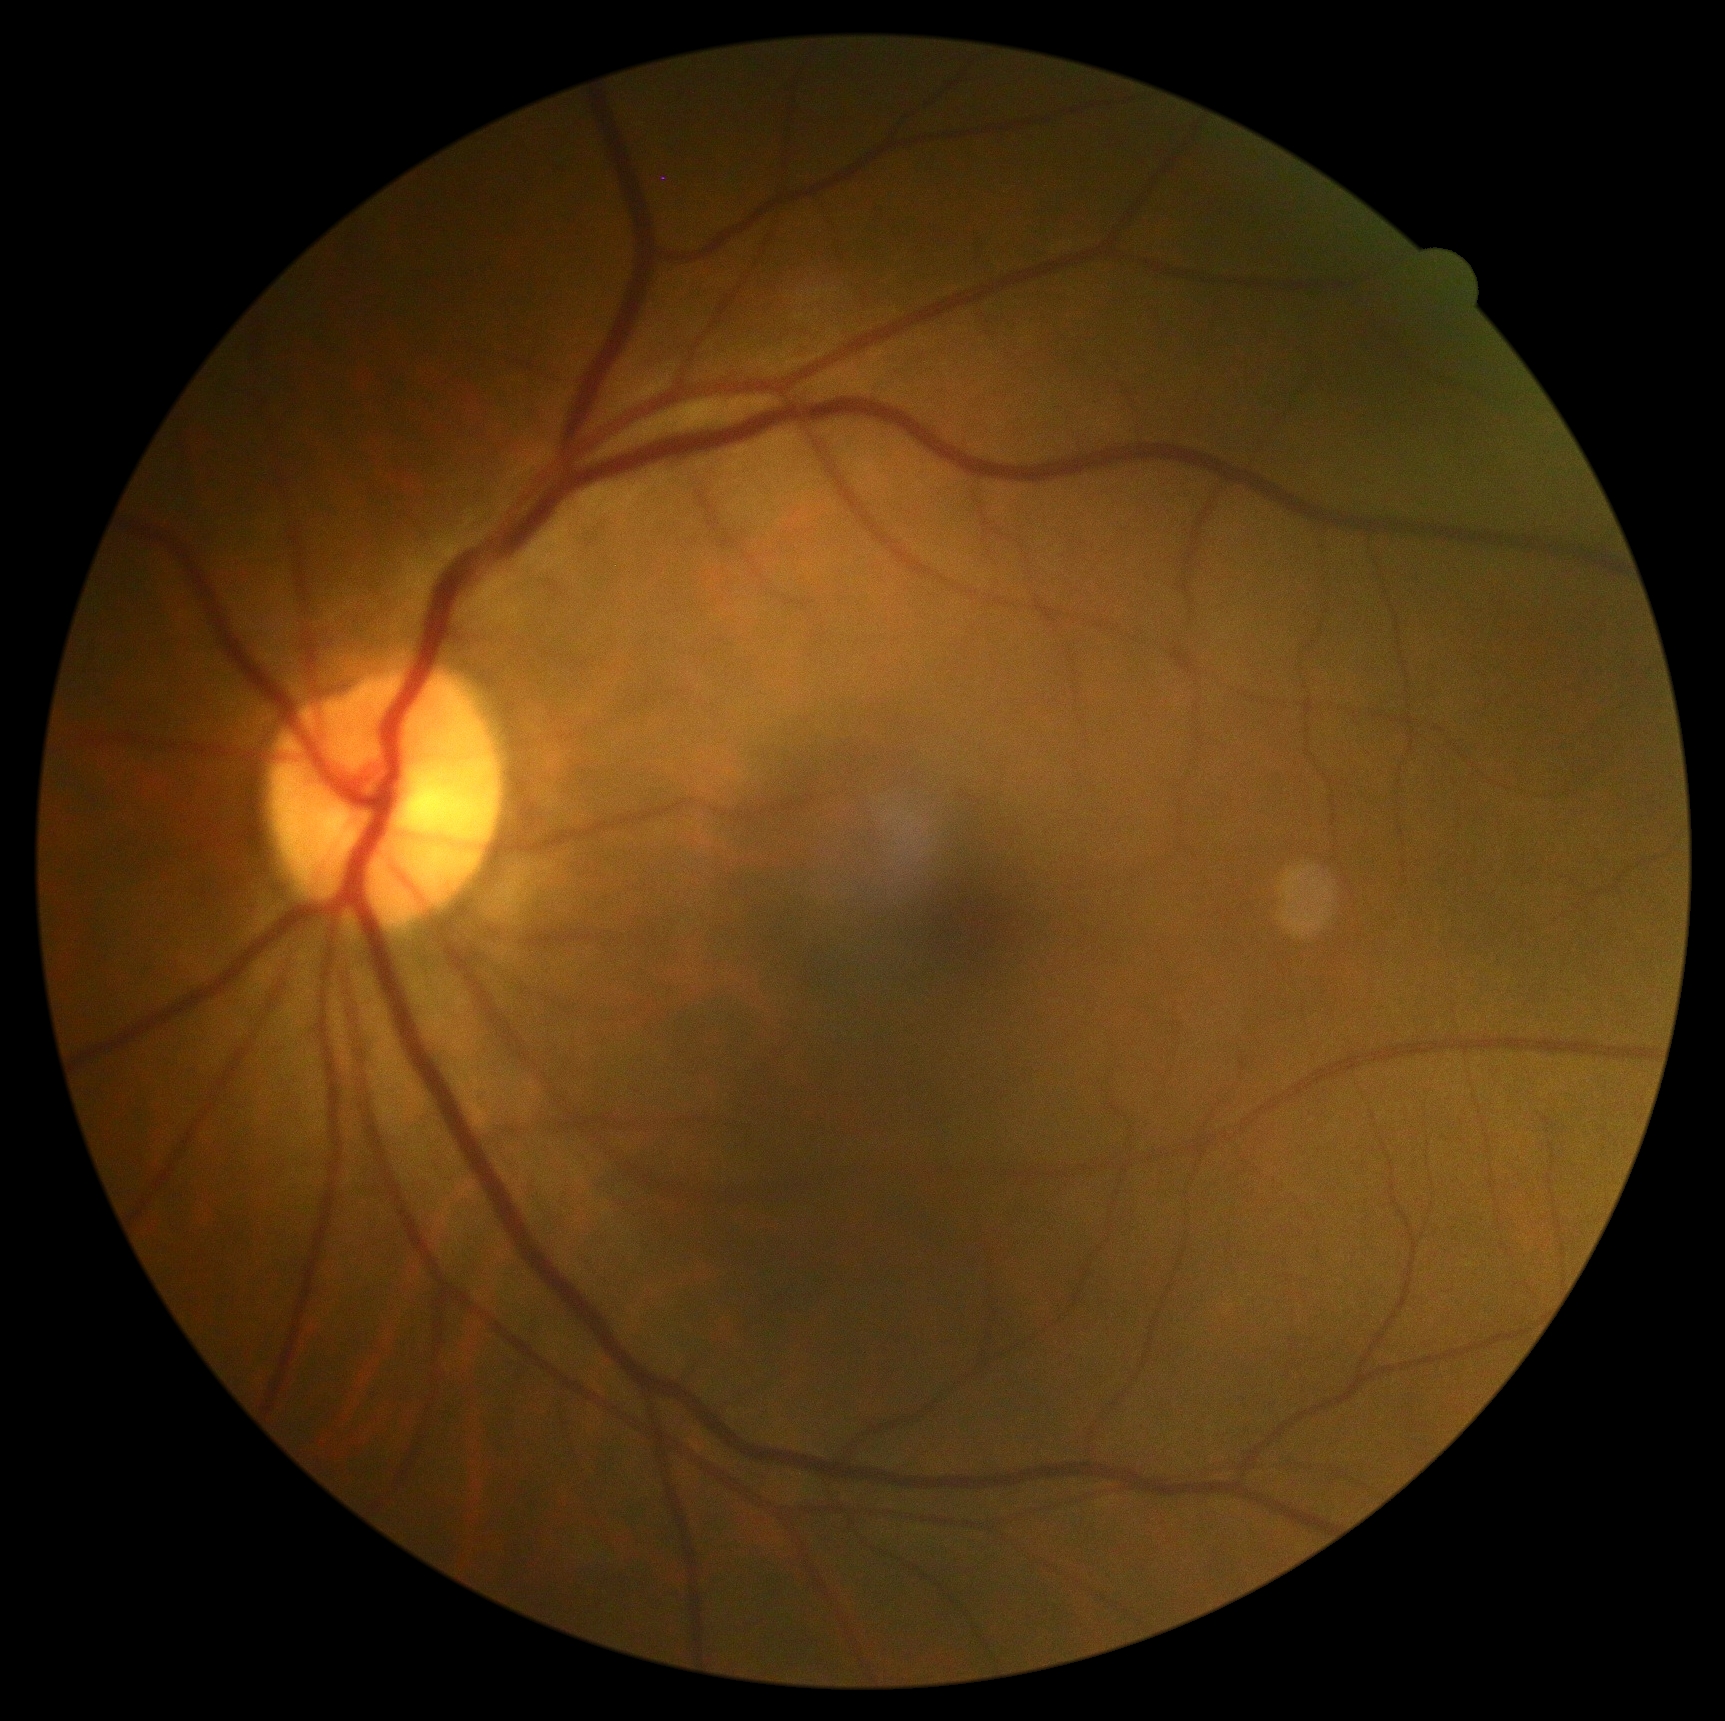
DR stage is grade 0 (no apparent retinopathy). No signs of diabetic retinopathy.